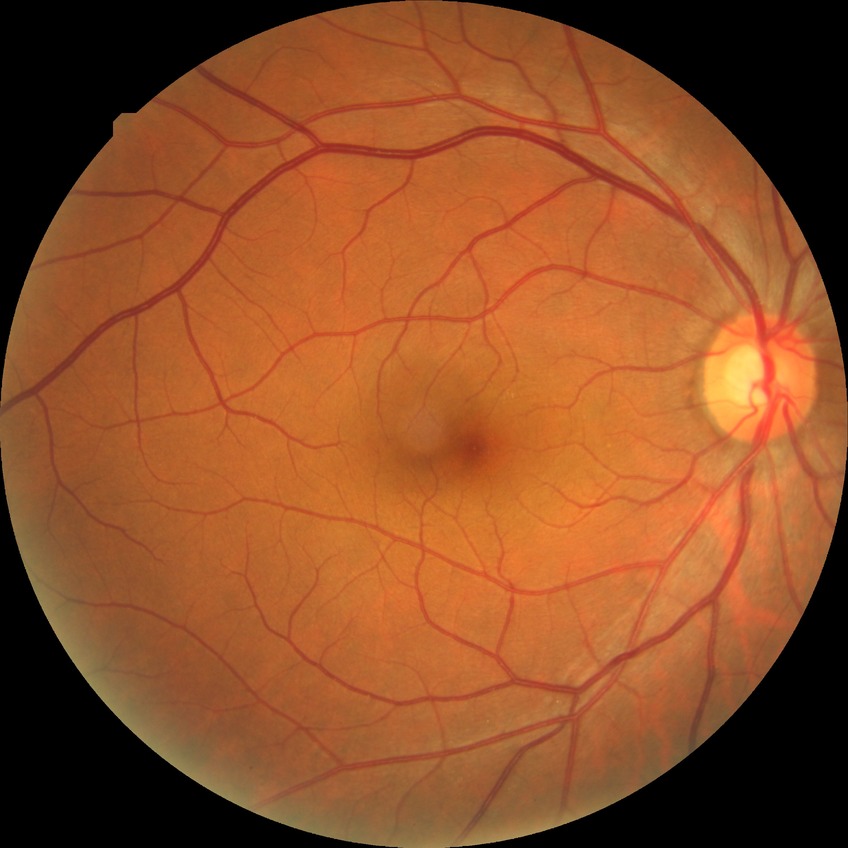 Modified Davis grading: no diabetic retinopathy.